Graded on the modified Davis scale, acquired with a NIDEK AFC-230, nonmydriatic fundus photograph, 848x848px.
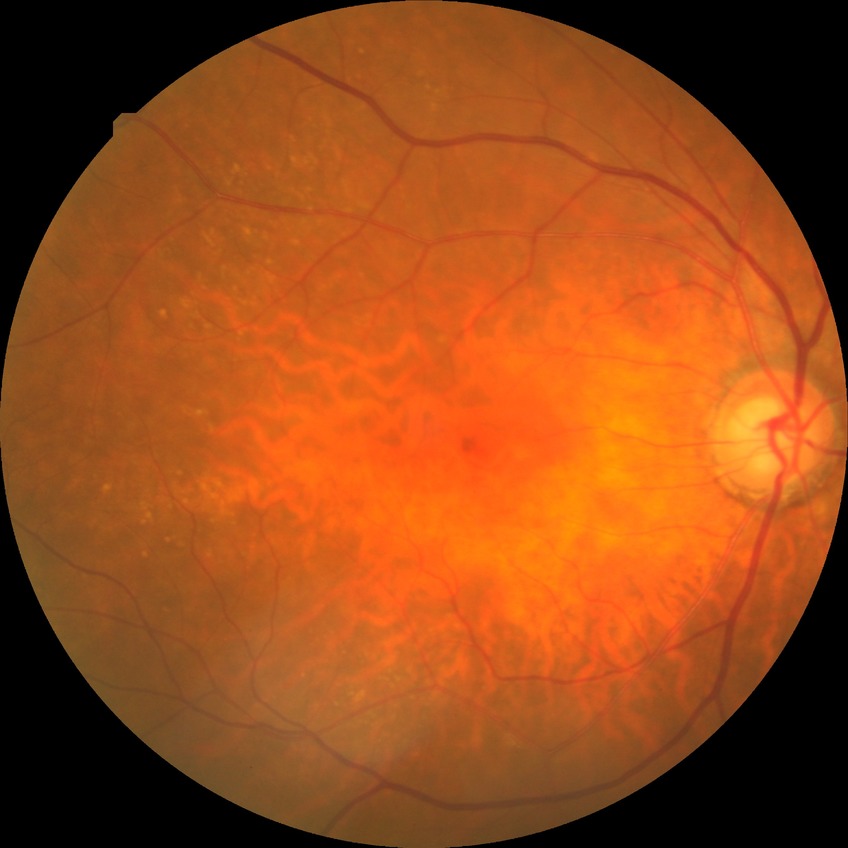

Assessment:
• retinopathy grade — no diabetic retinopathy